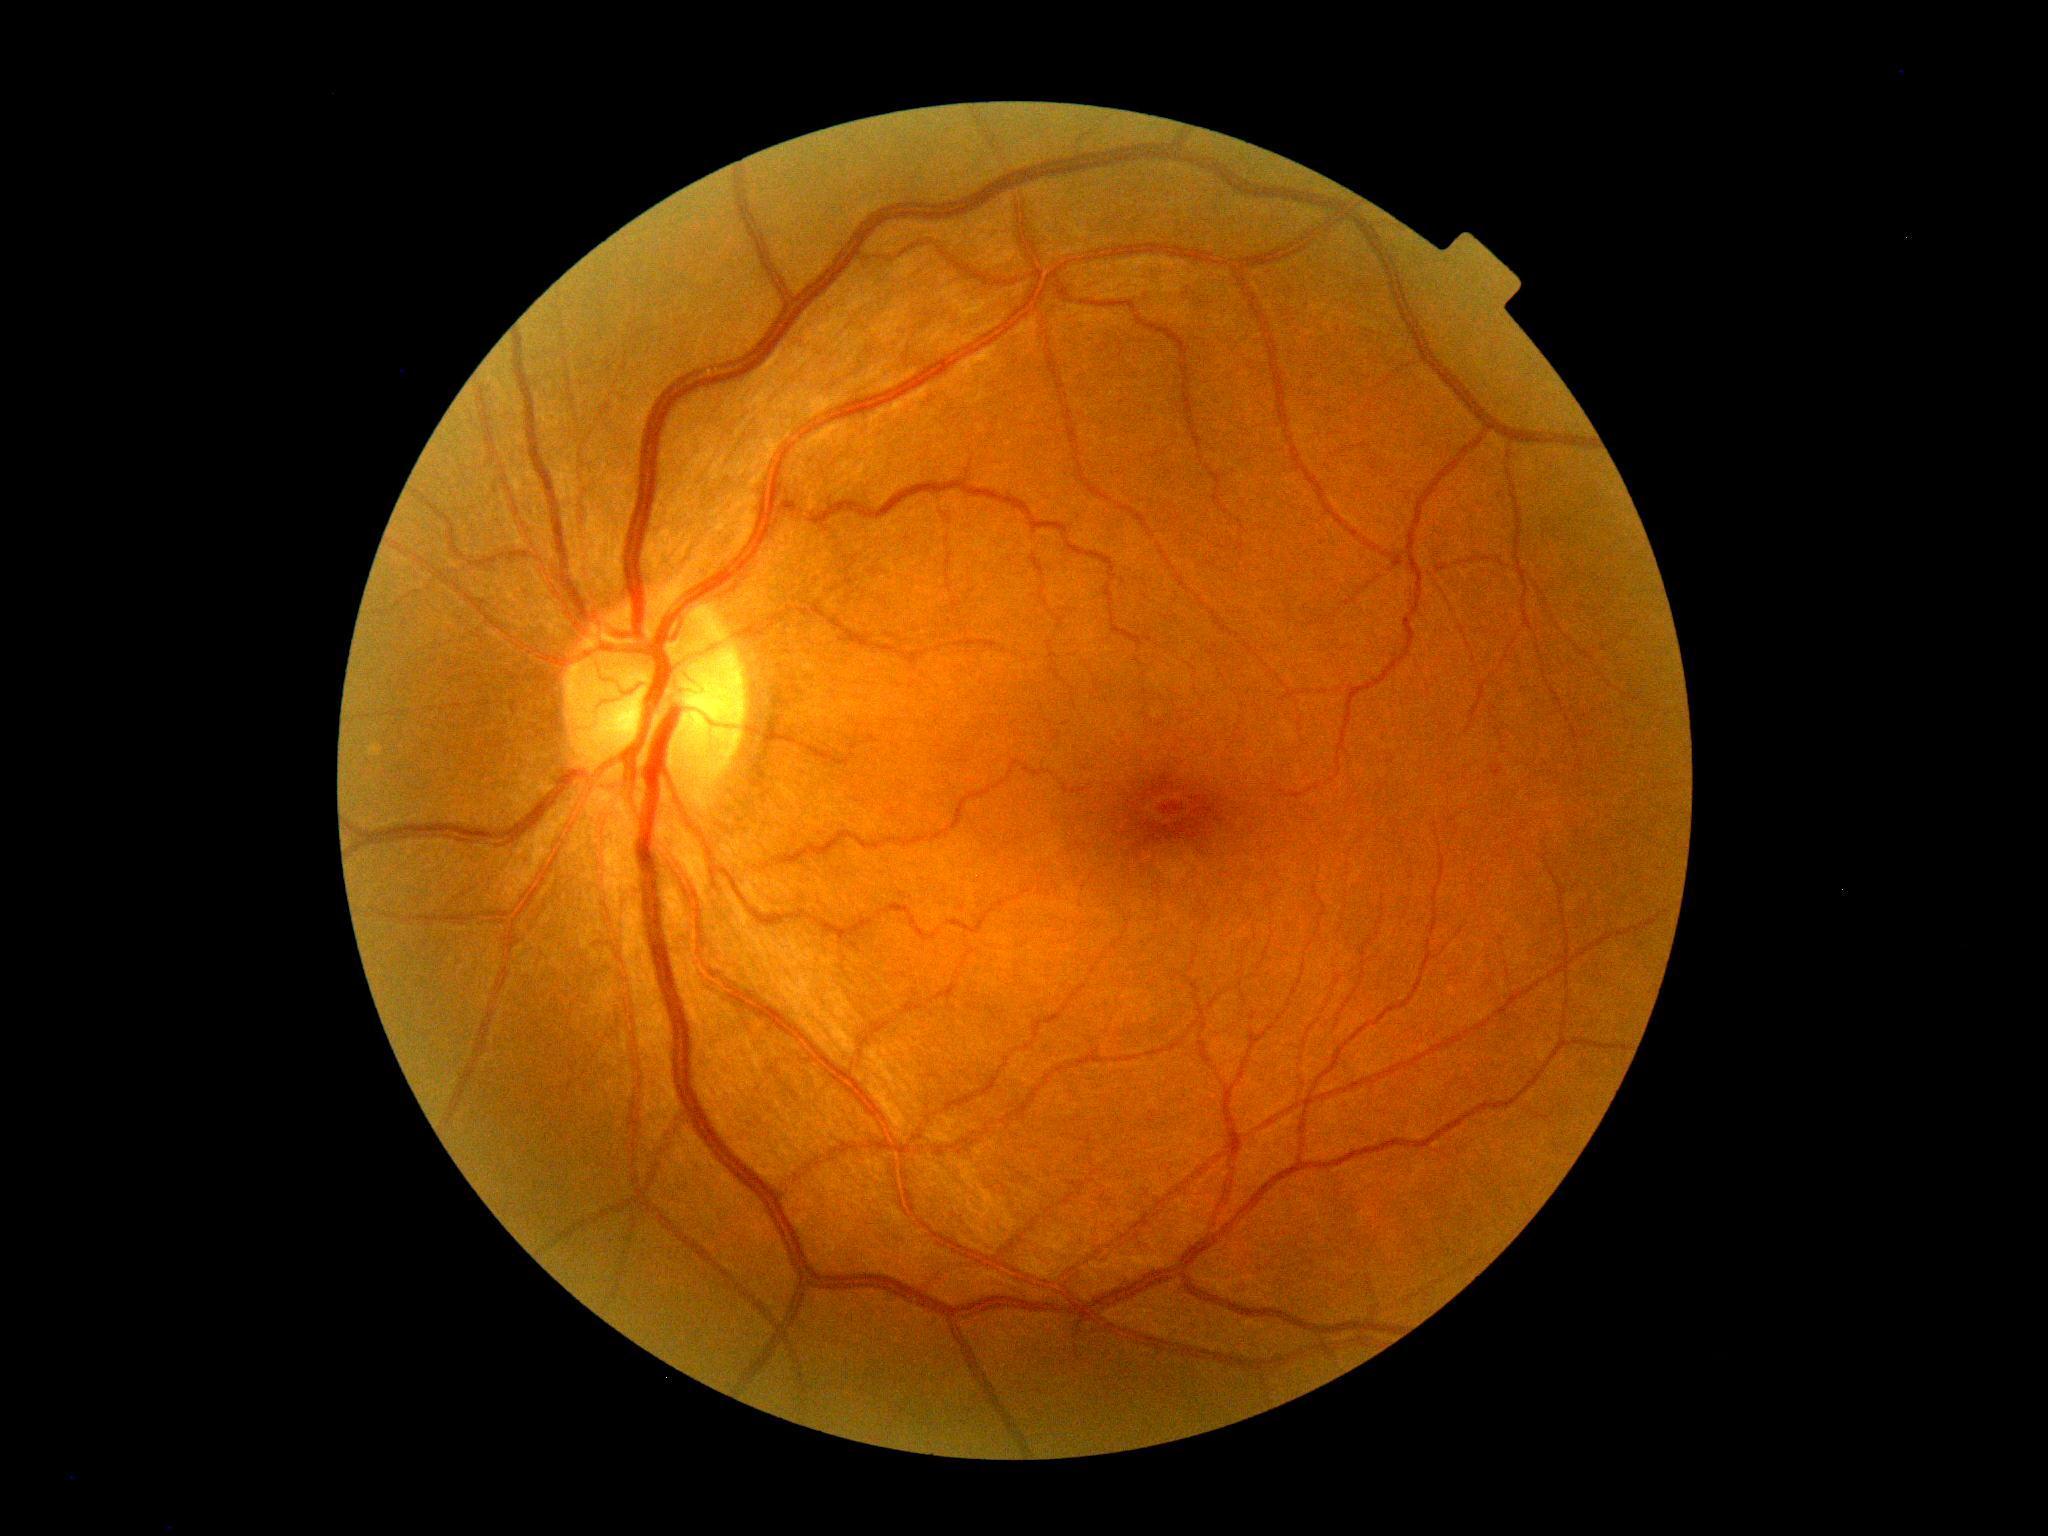
DR stage is grade 1 (mild NPDR).